45° FOV, color fundus image: 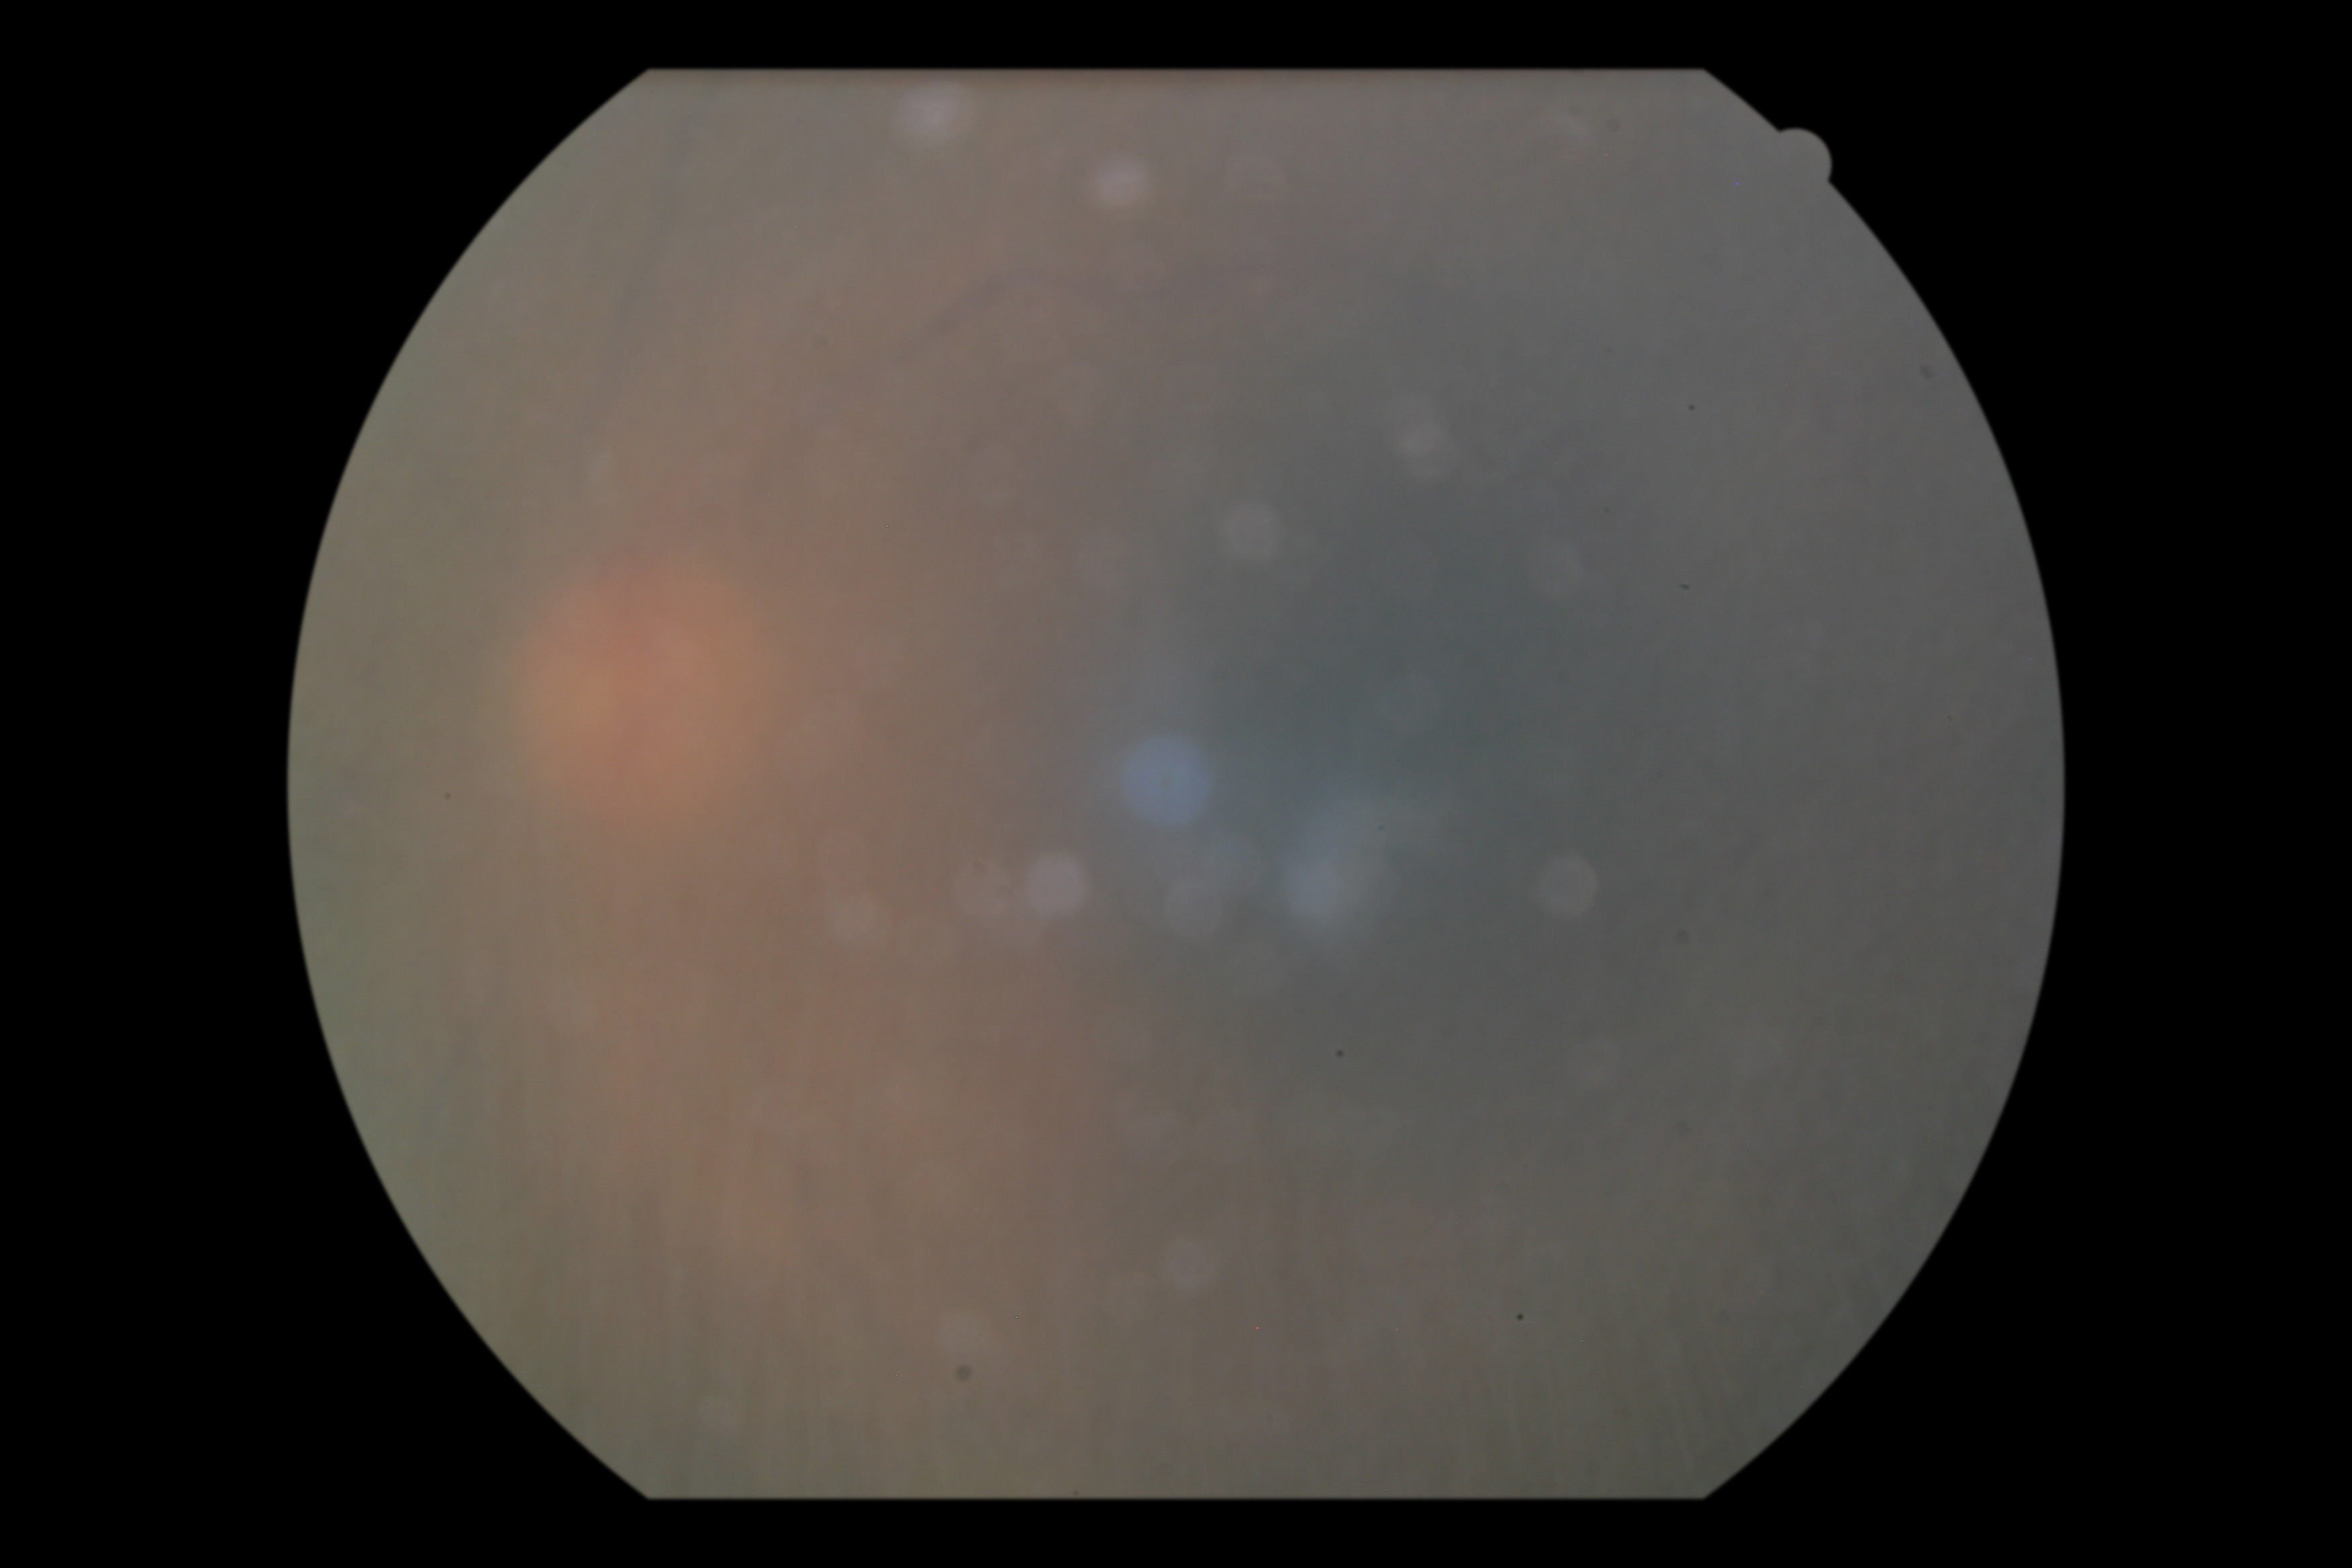

image quality: below grading threshold | diabetic retinopathy severity: ungradable due to poor image quality.